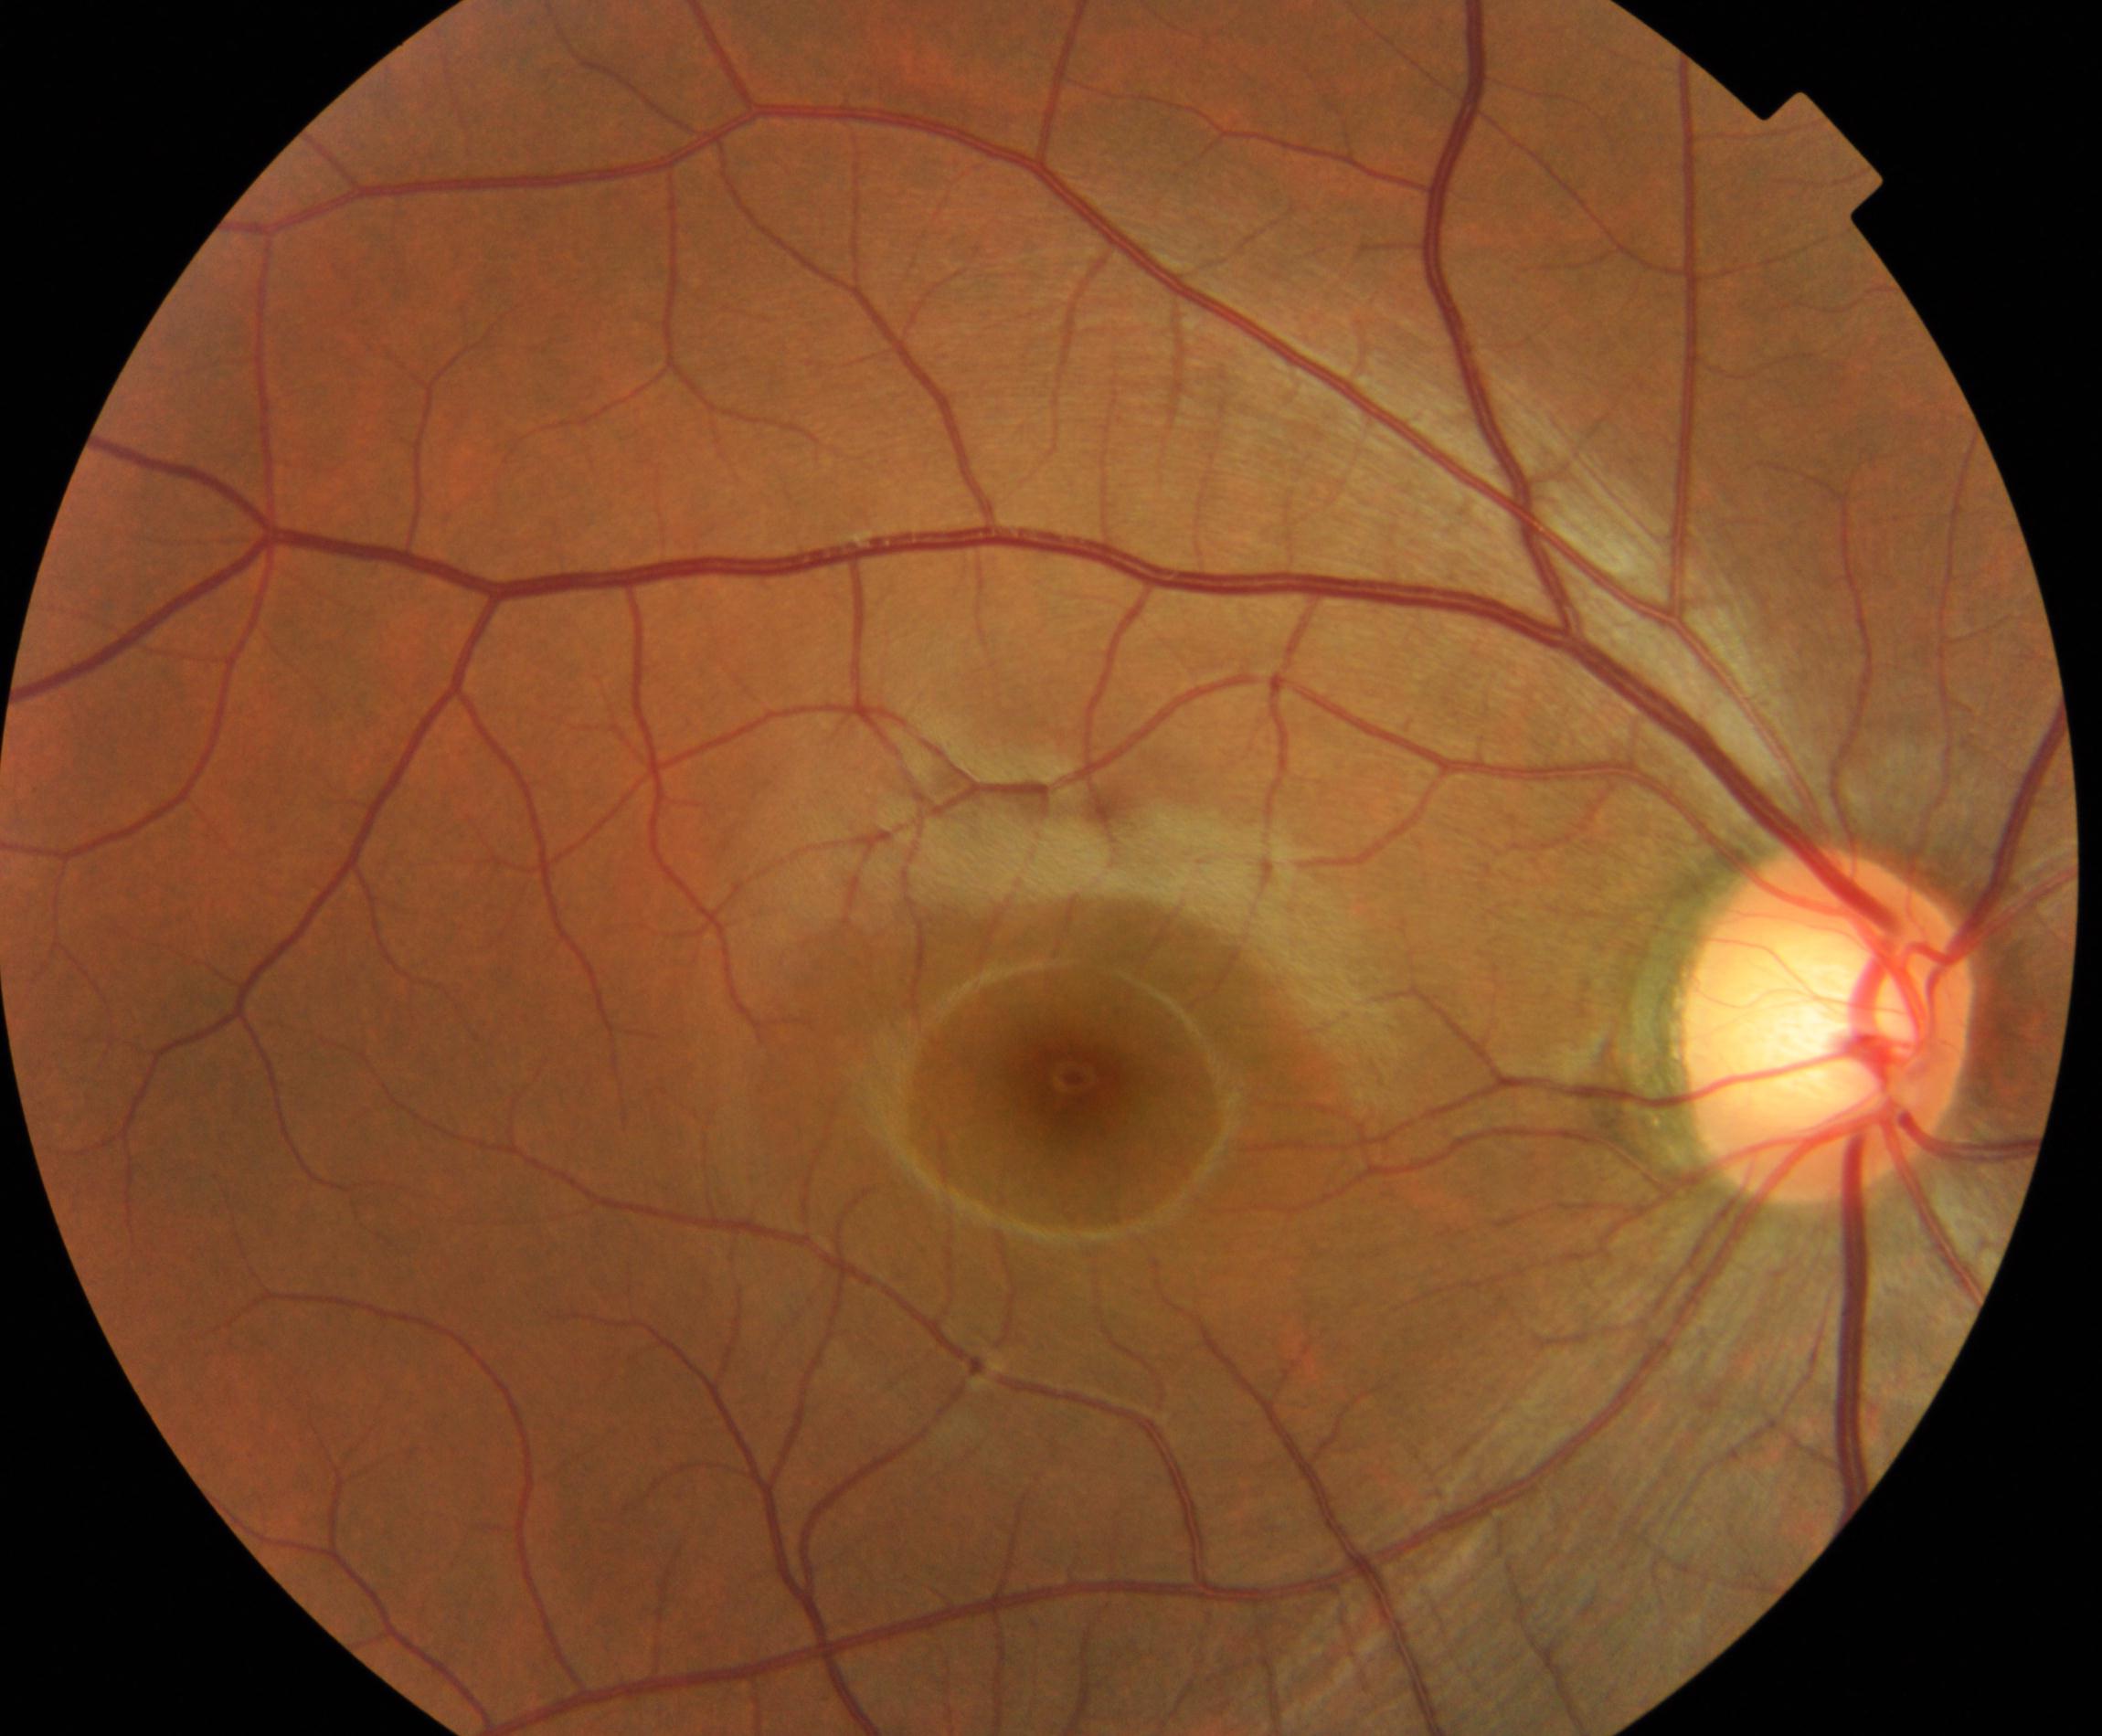
Consistent with large optic cup.